DR severity per modified Davis staging · acquired with a NIDEK AFC-230 — 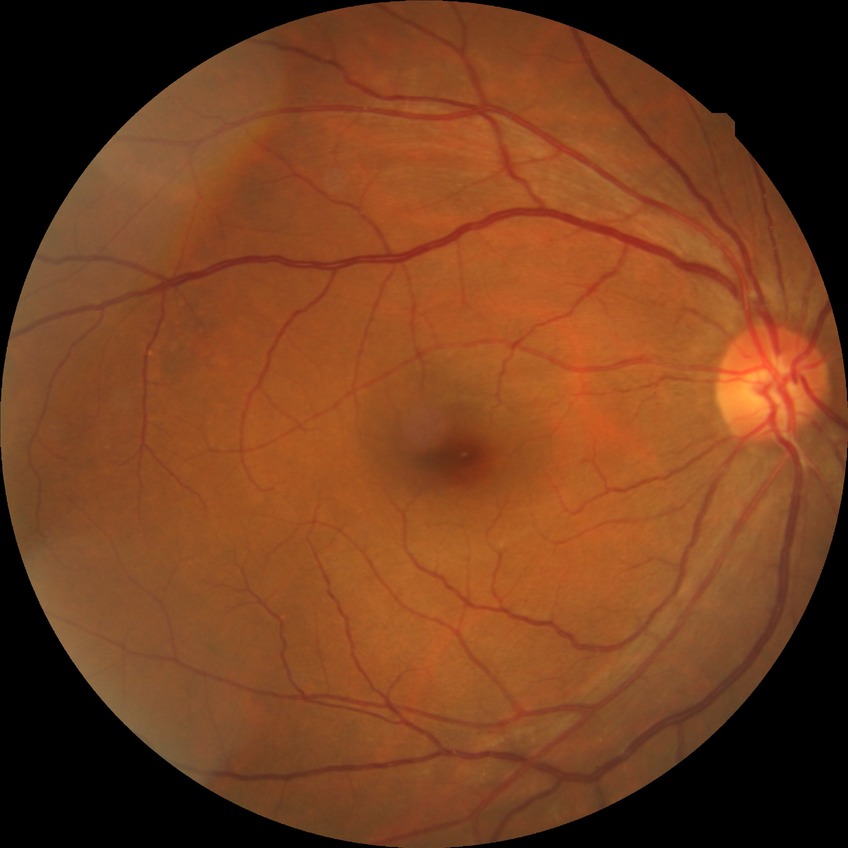
No signs of diabetic retinopathy. DR is NDR.